Camera: Phoenix ICON (100° FOV). Image size 1240x1240. Pediatric retinal photograph (wide-field).
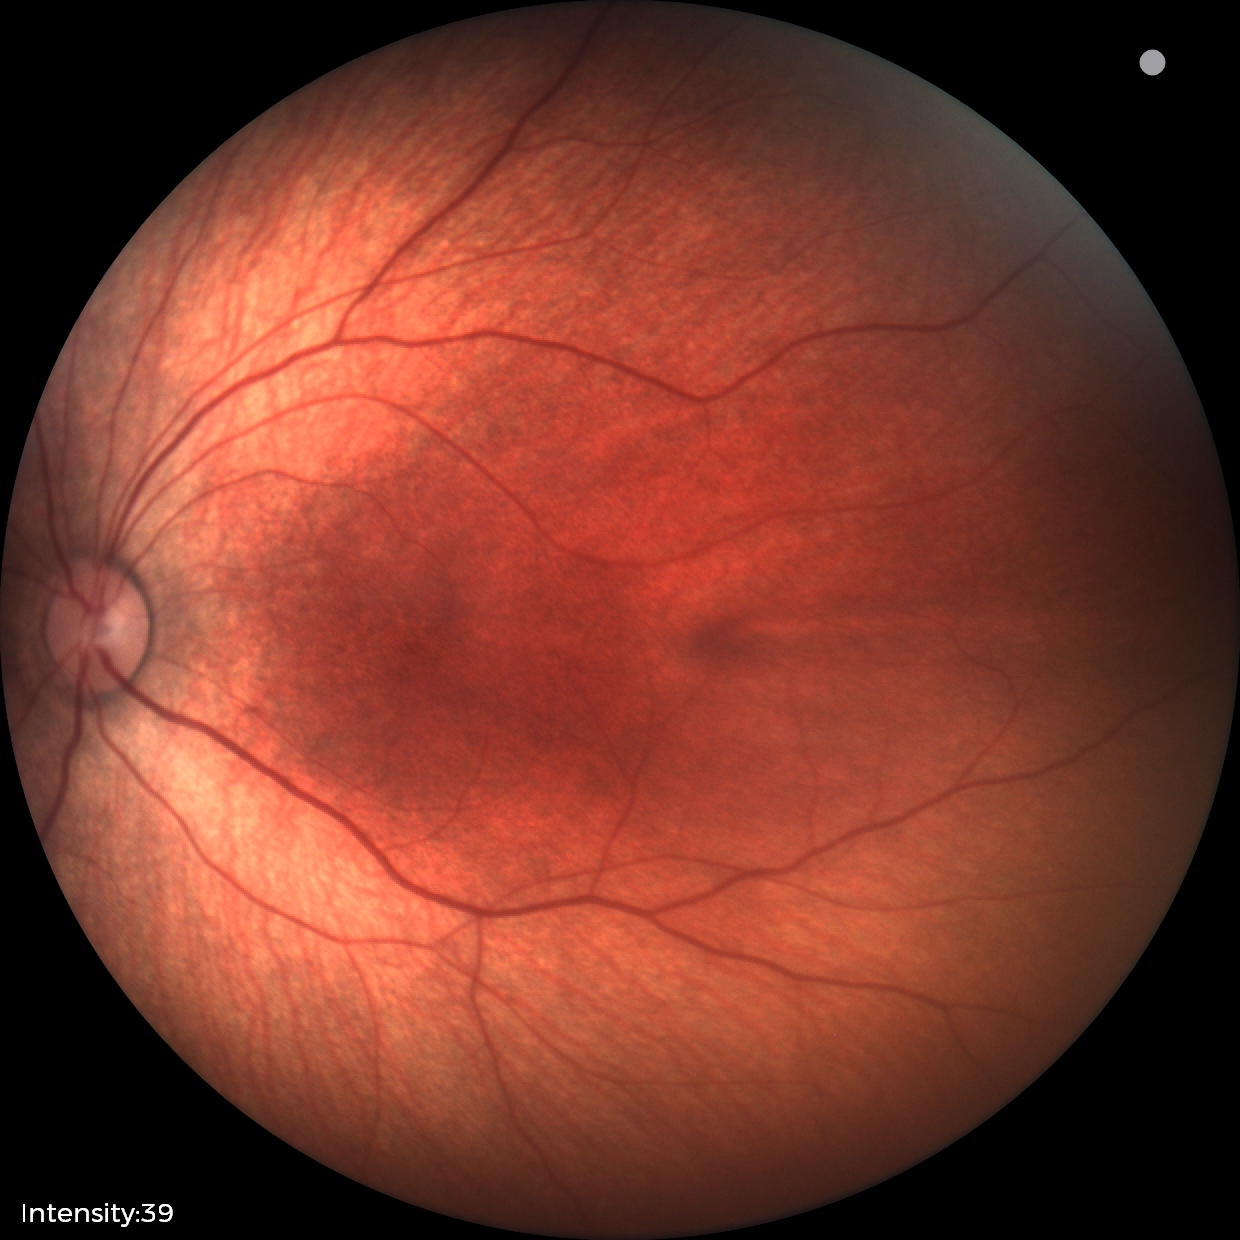 Physiological retinal appearance for postconceptual age.